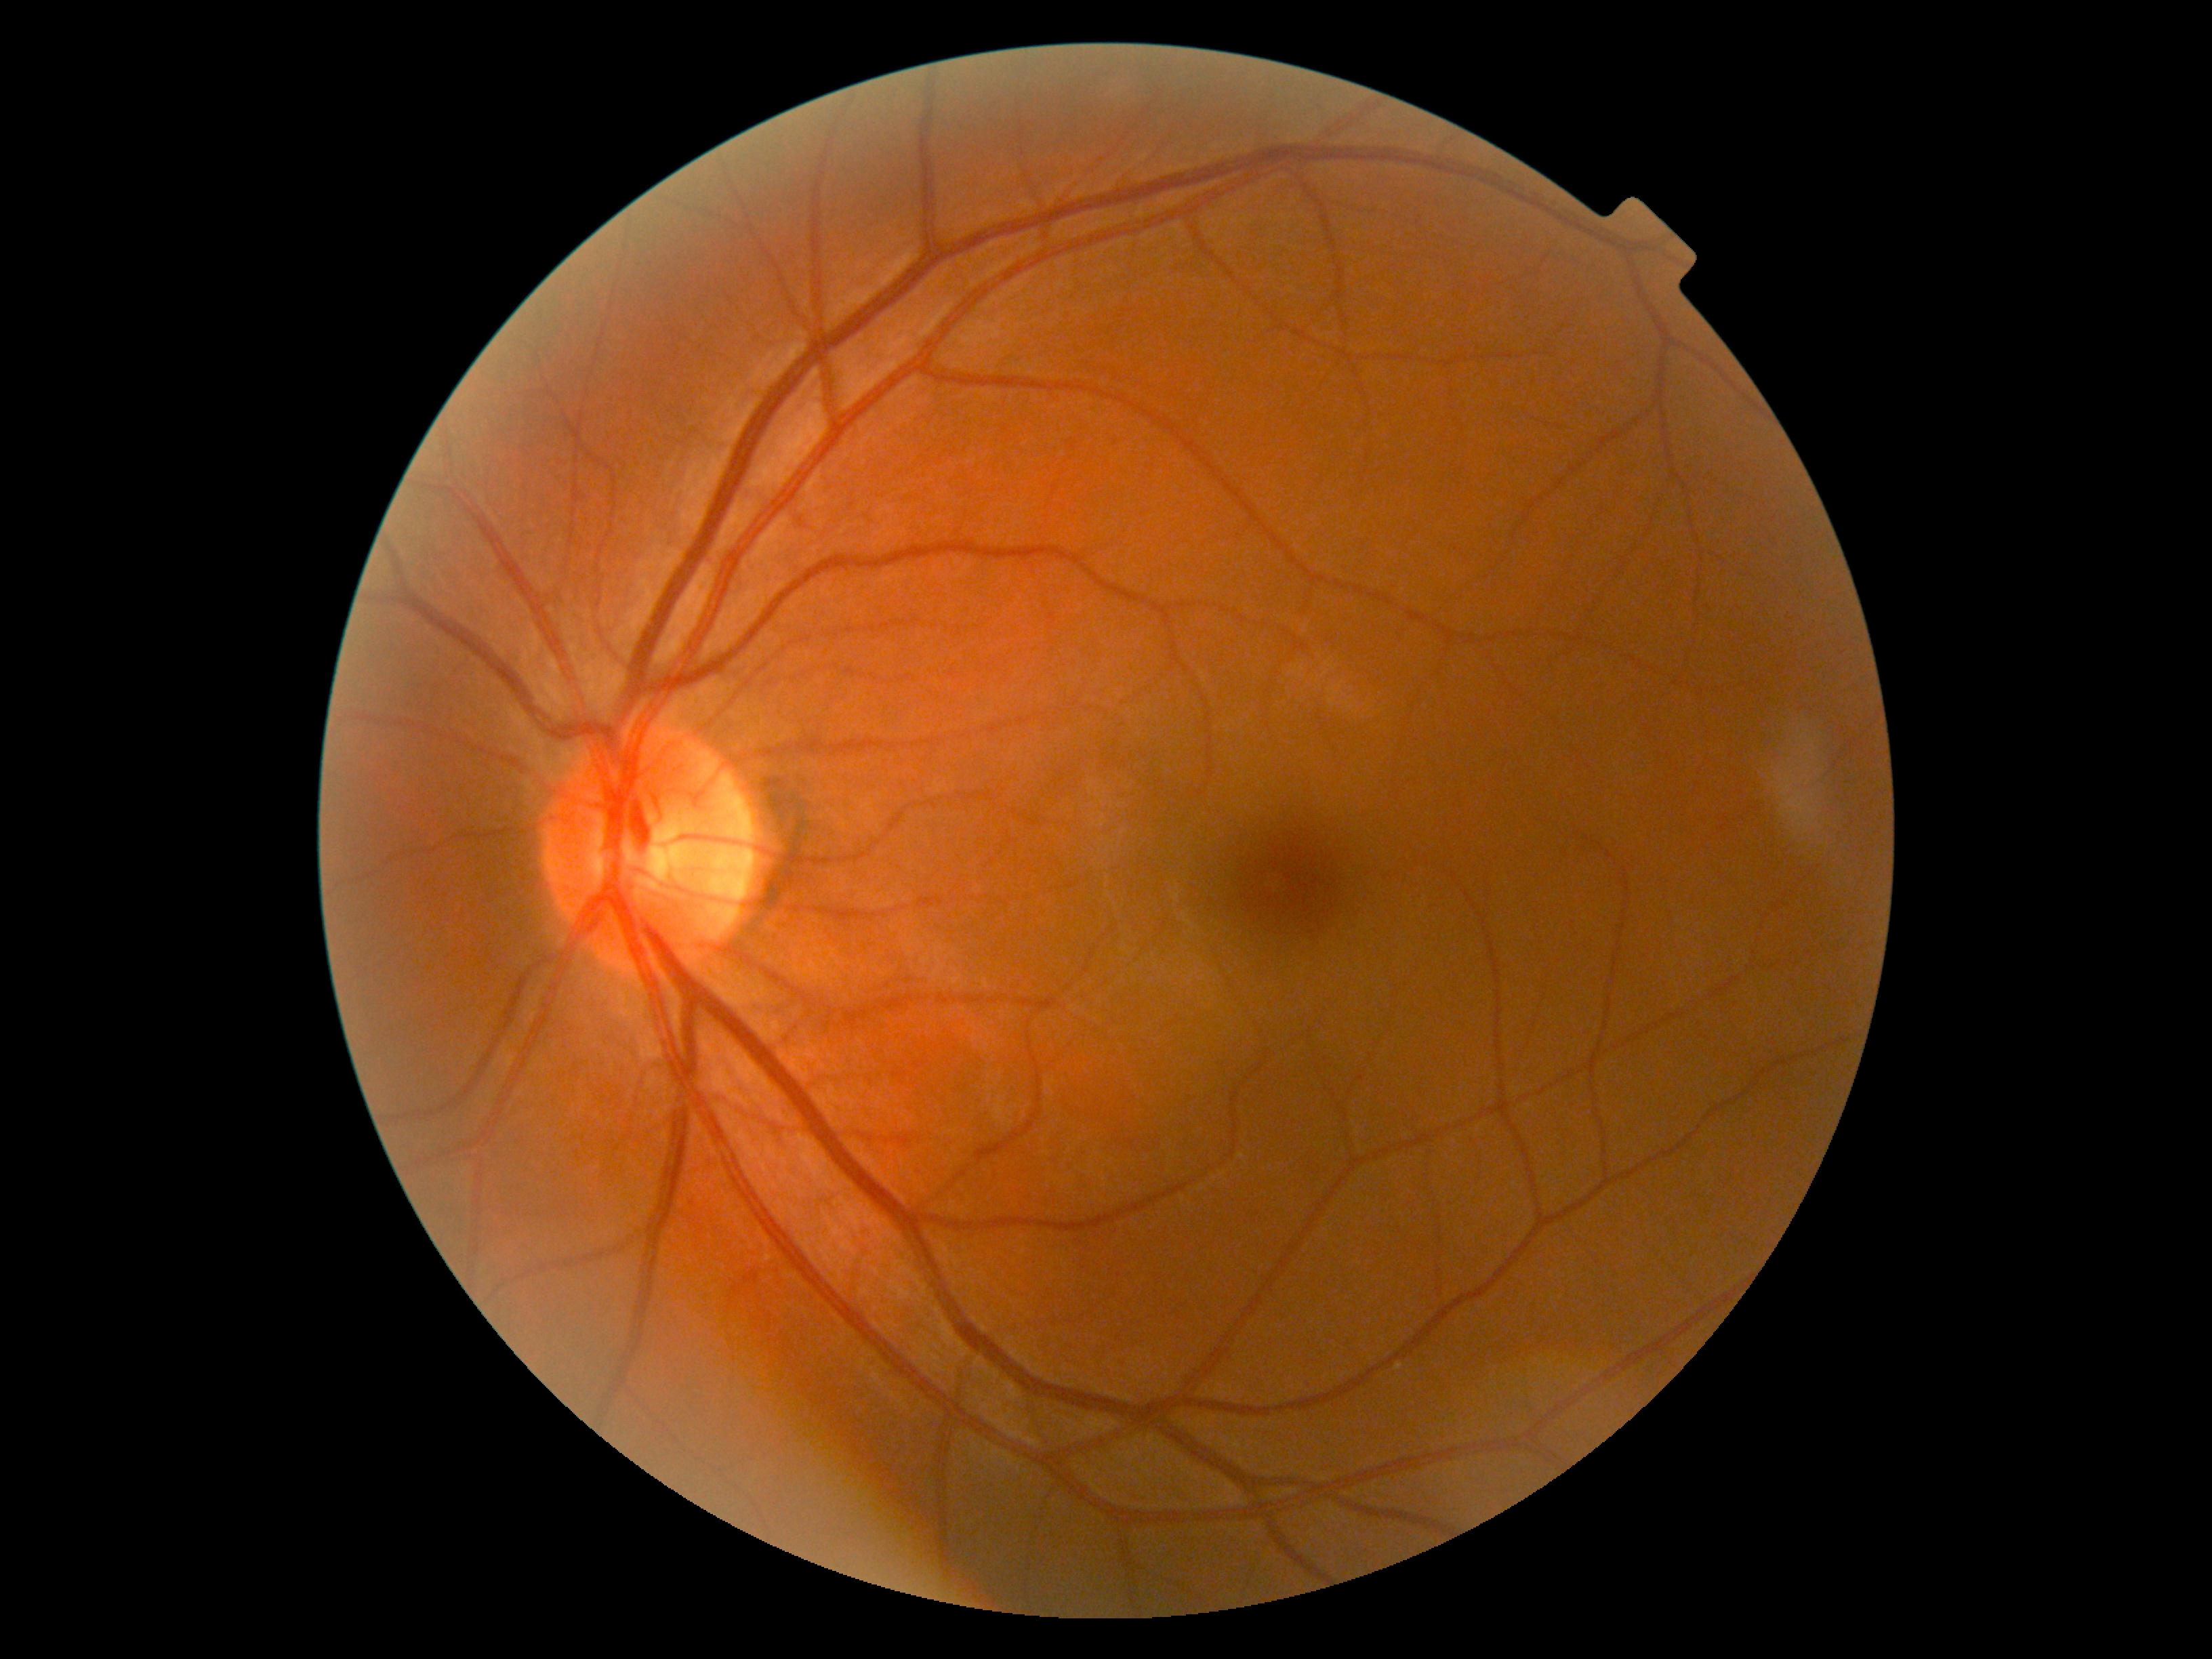

Retinopathy grade is no apparent diabetic retinopathy (0).